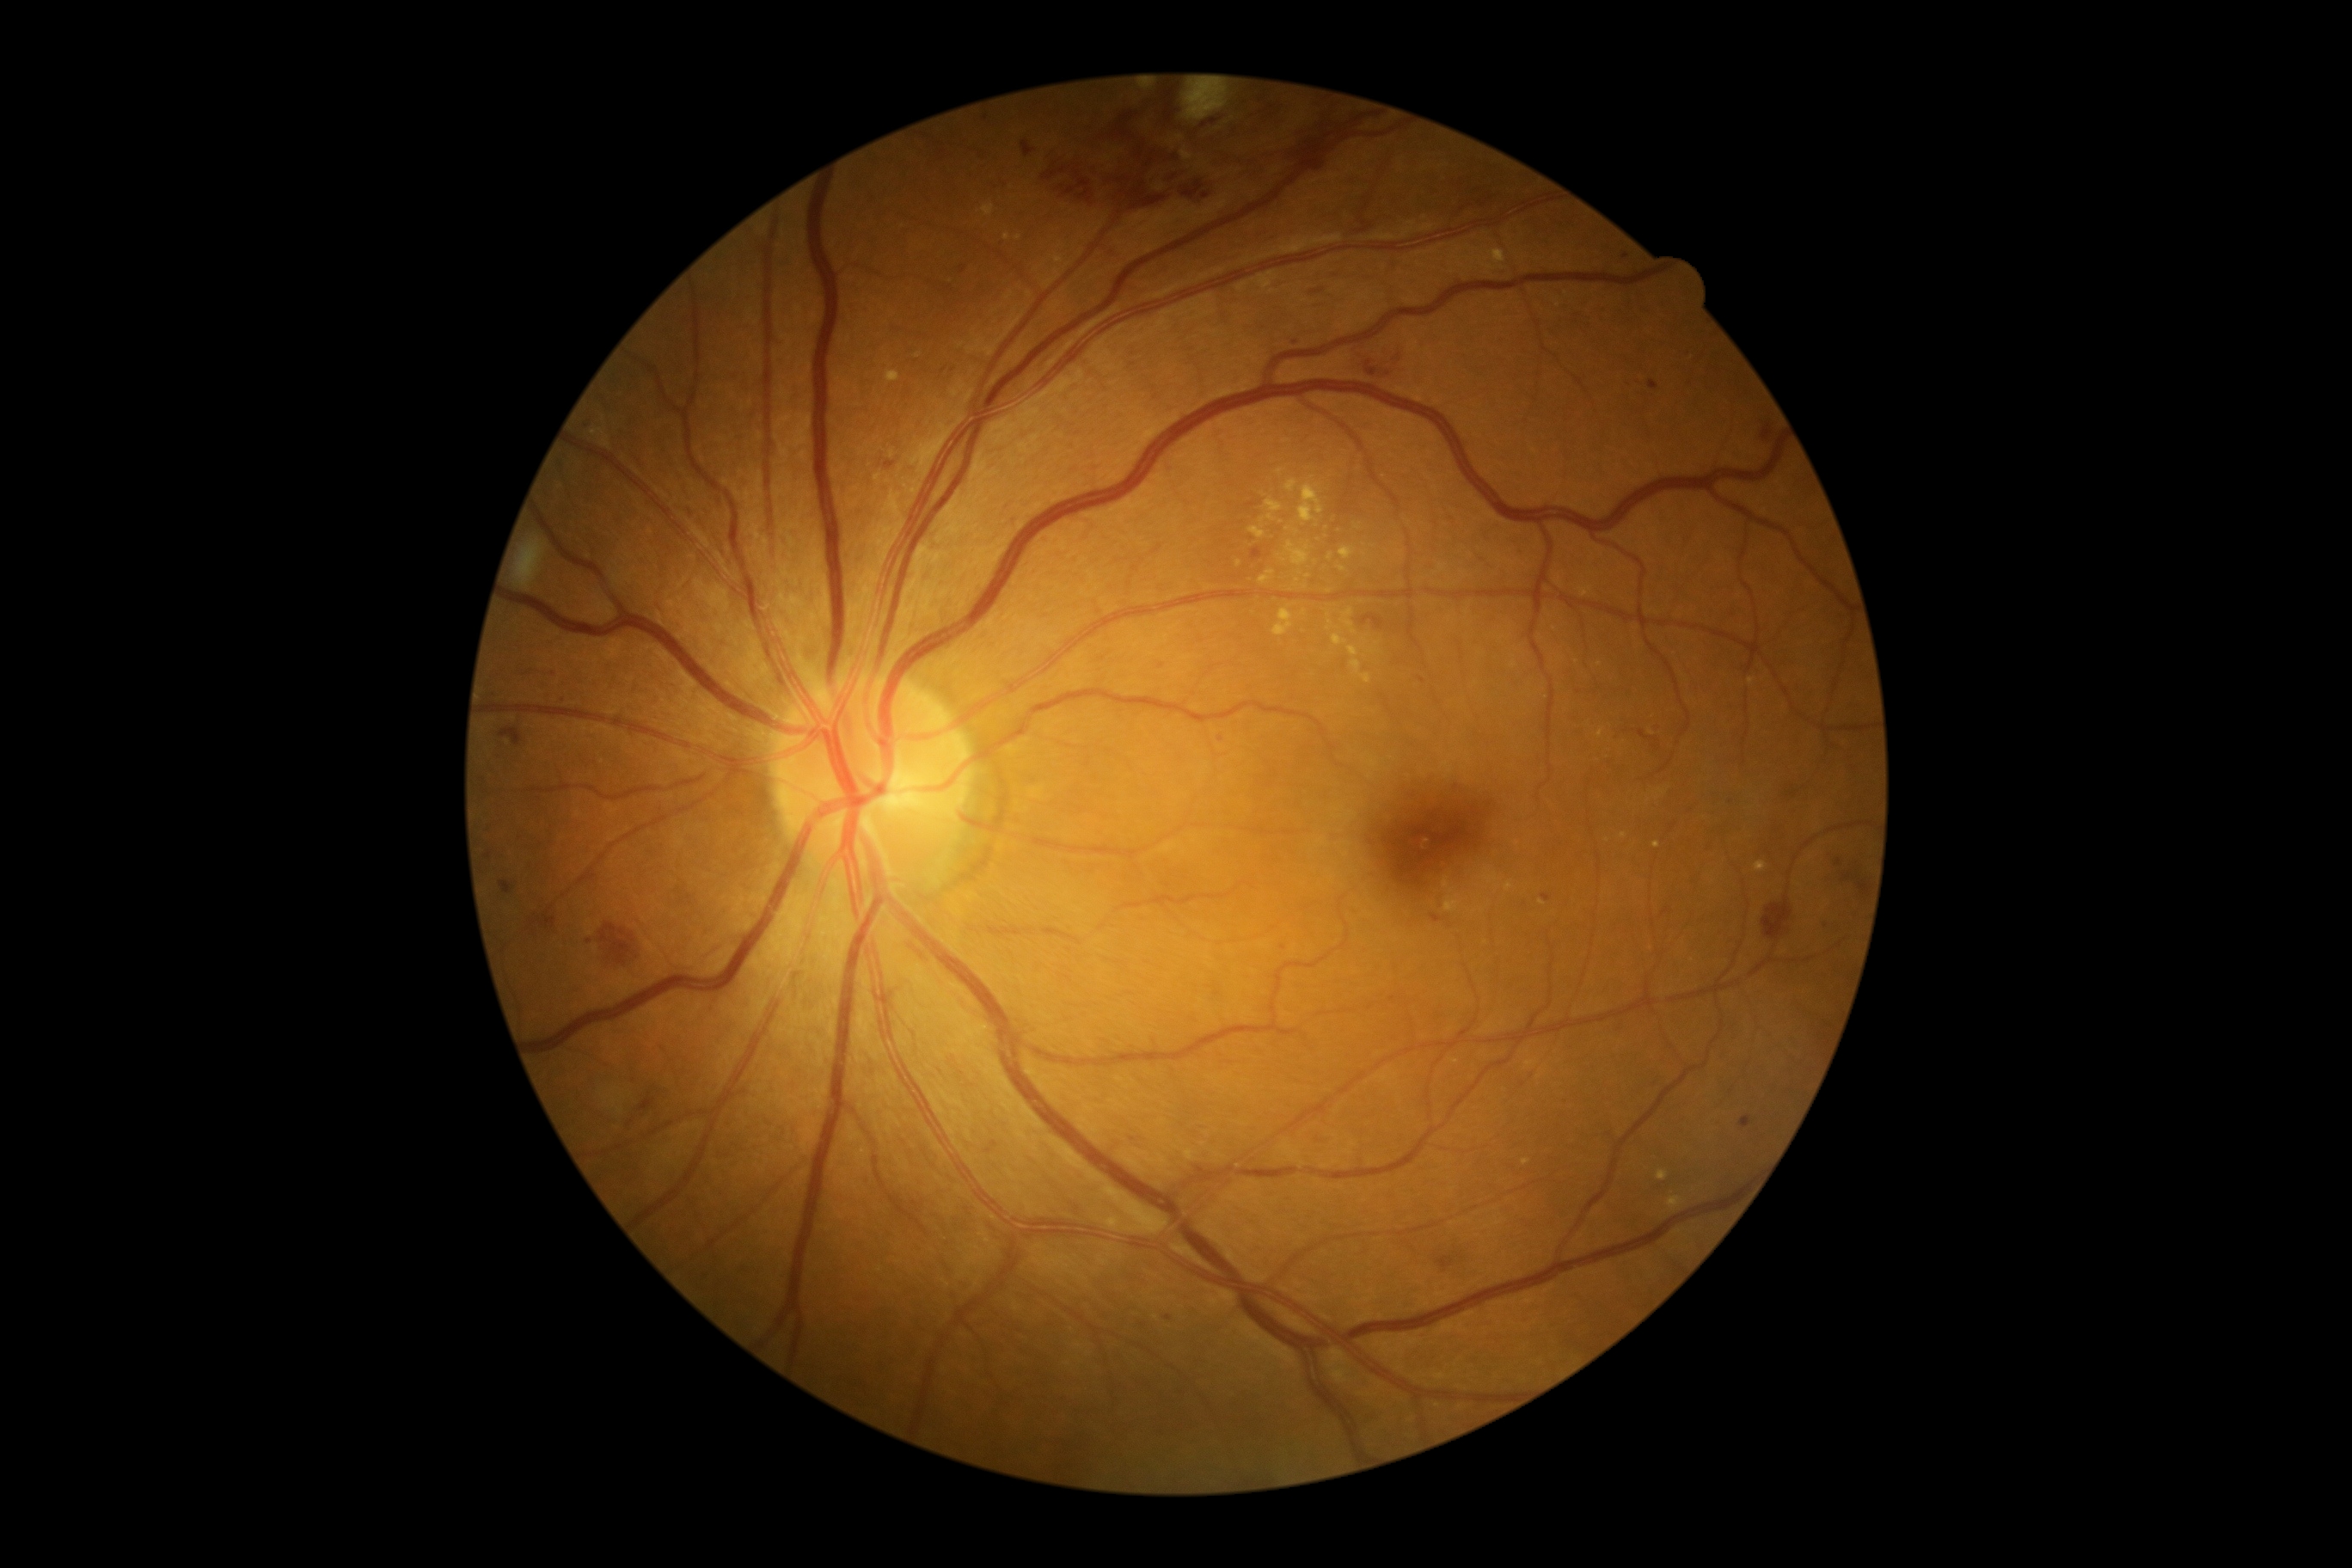
Disease class: non-proliferative diabetic retinopathy. Diabetic retinopathy (DR) is 2.